2352 x 1568 pixels: 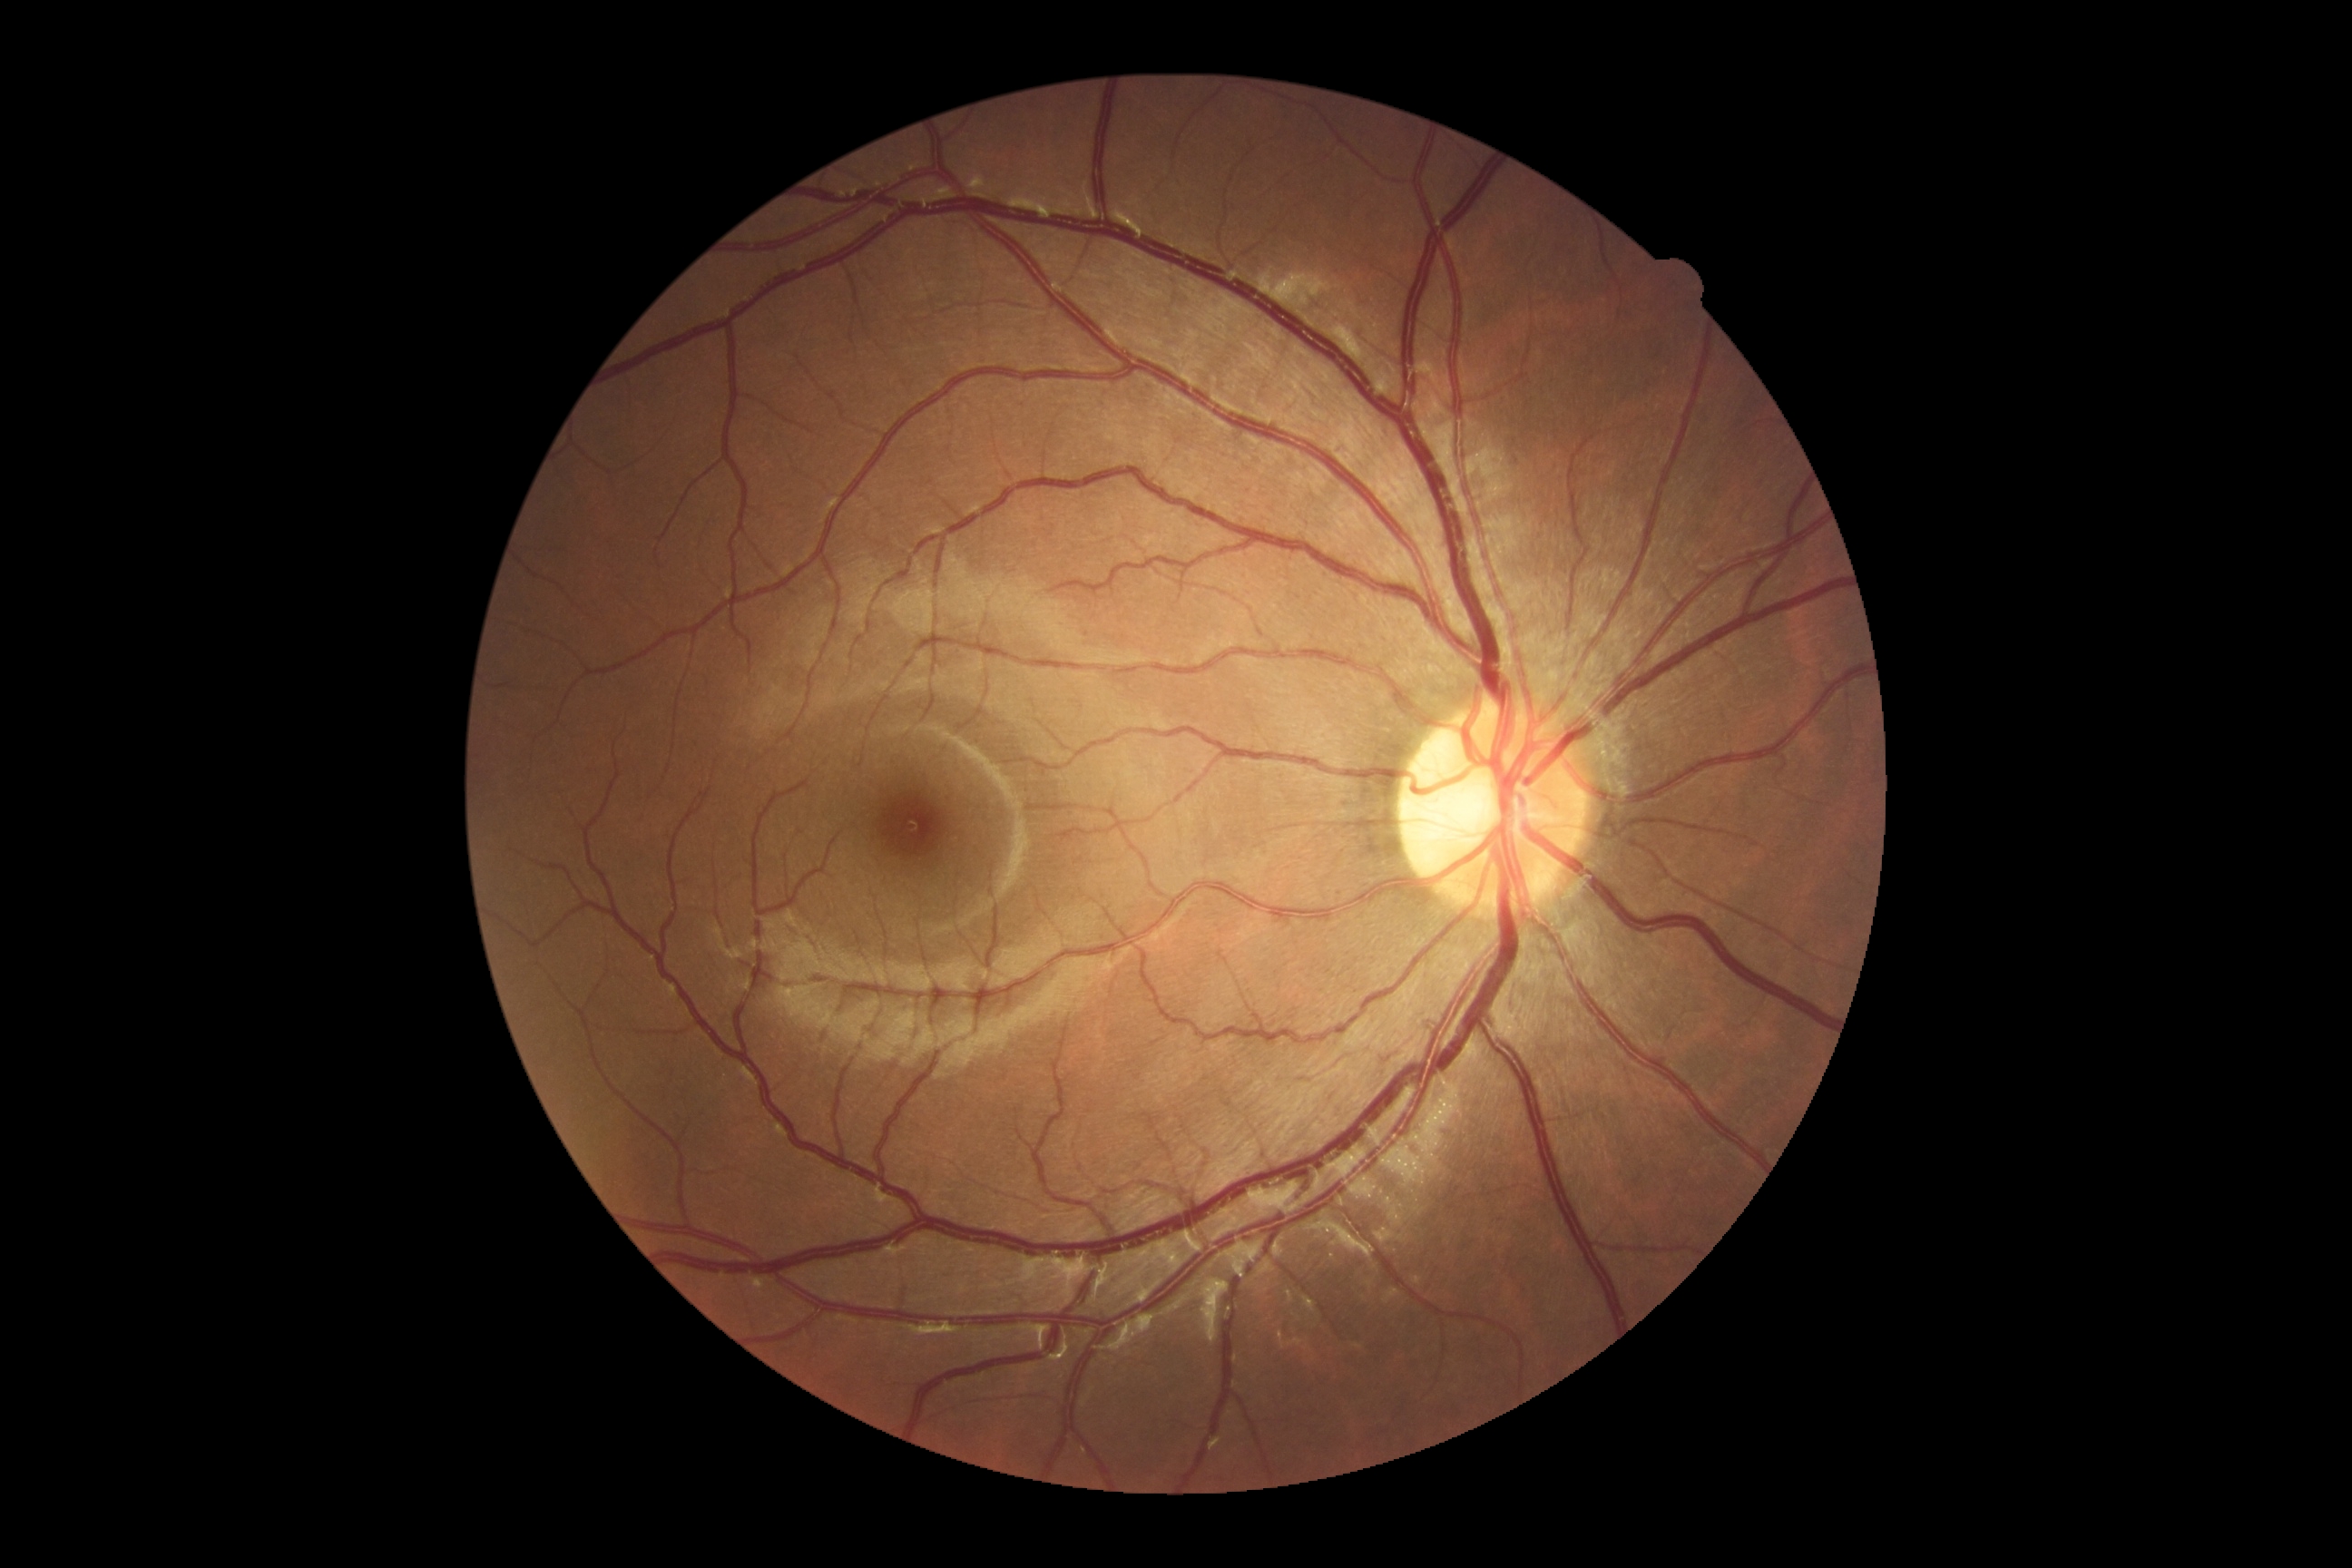 DR is grade 0 (no apparent retinopathy).